2106x1630px.
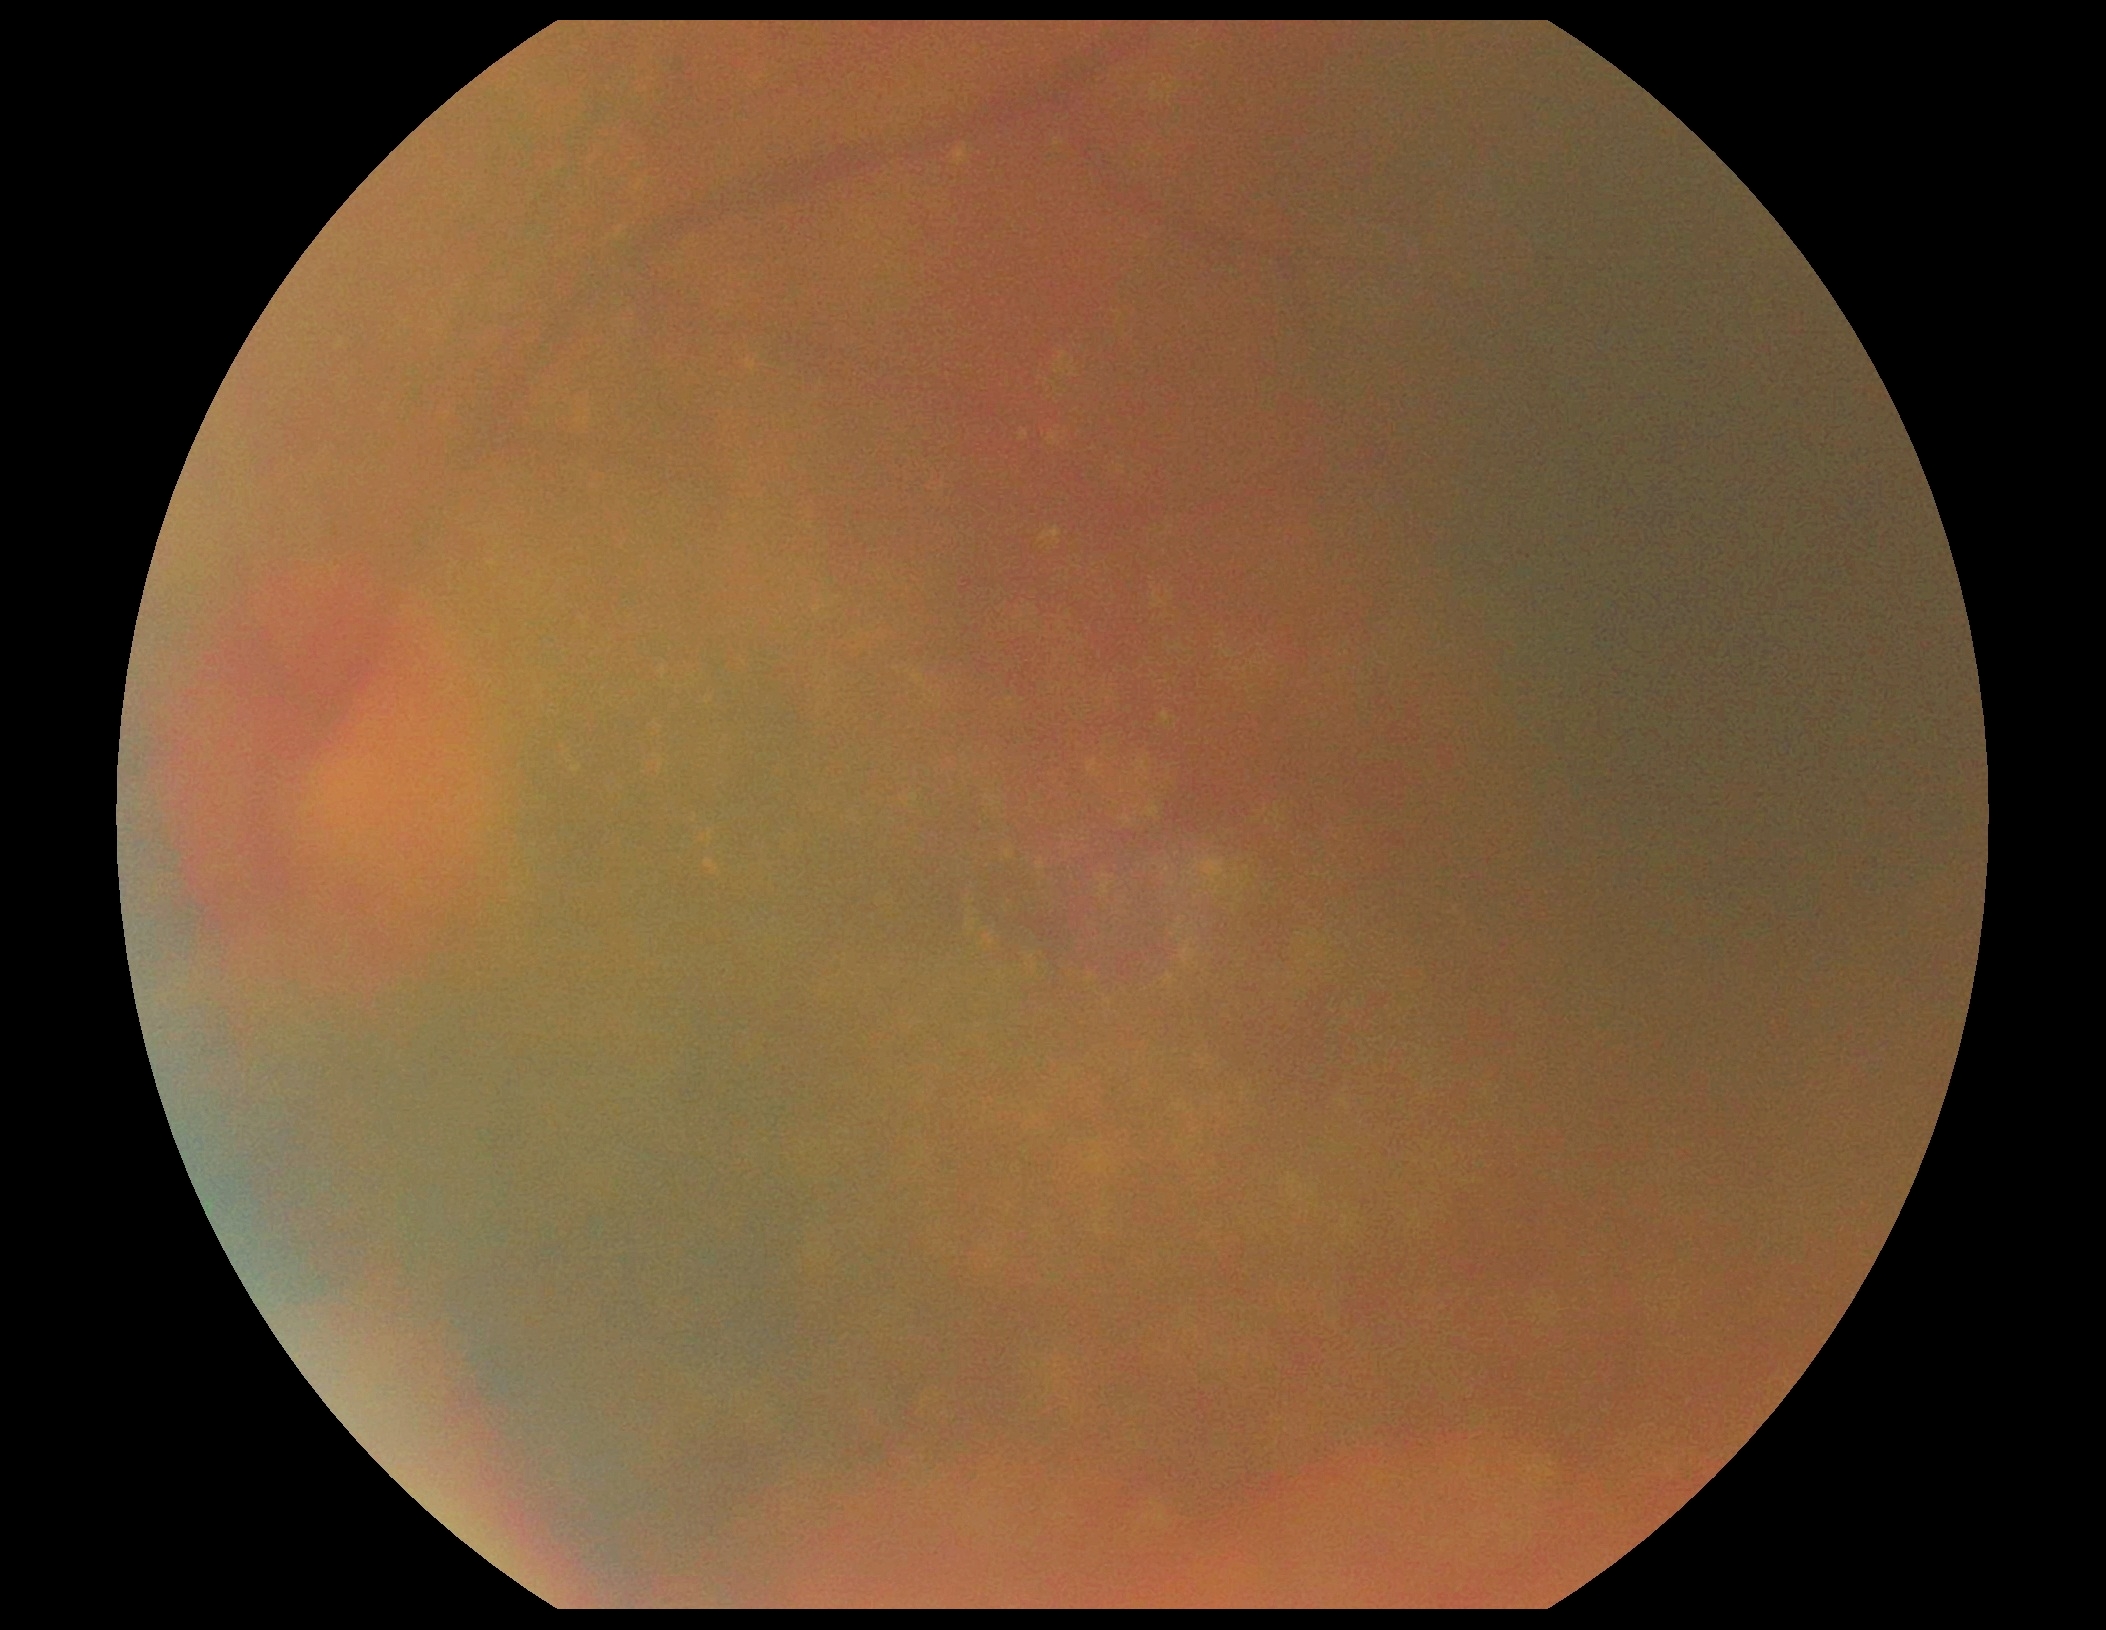

image quality = insufficient, diabetic retinopathy = ungradable due to poor image quality.